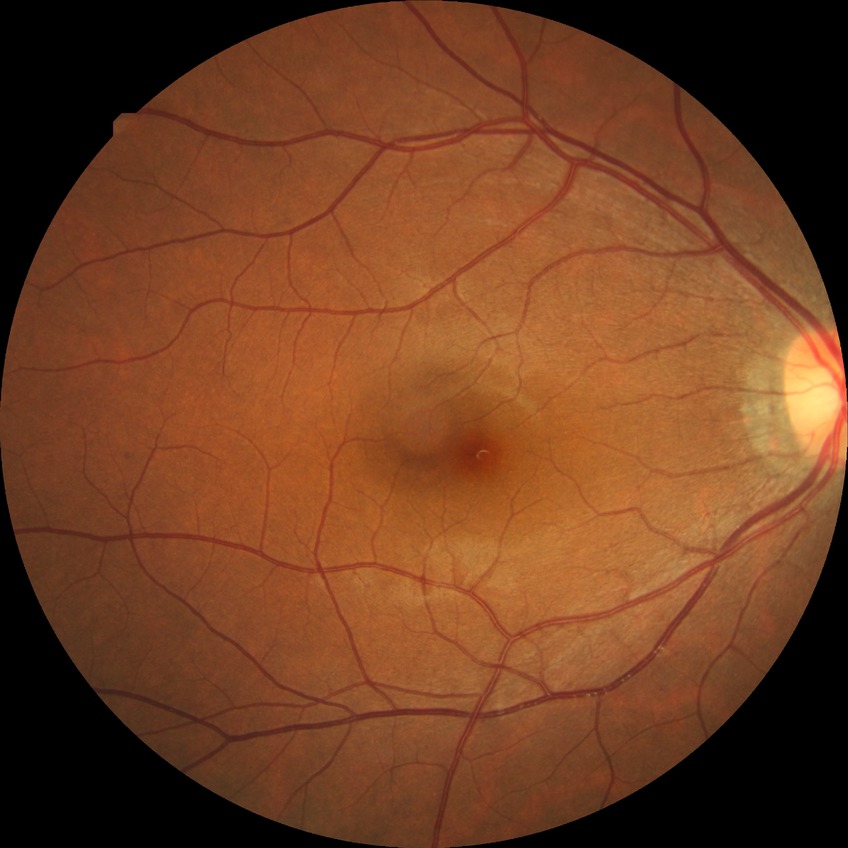
diabetic retinopathy grade@no diabetic retinopathy.